Wide-field contact fundus photograph of an infant. 640x480: 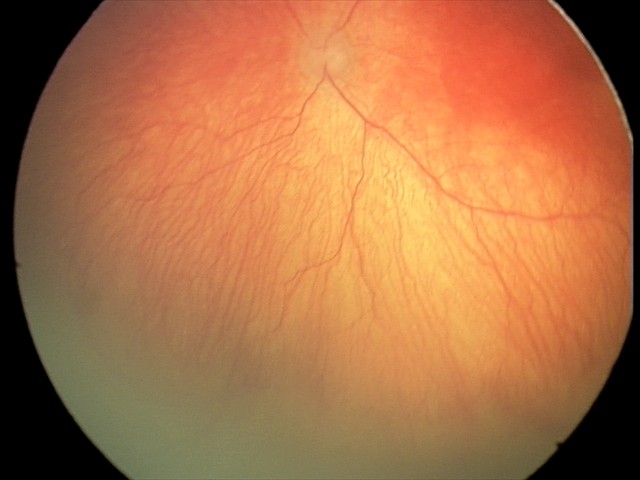
Plus disease present.
Examination diagnosed as A-ROP (aggressive ROP).